2352x1568px. 45° field of view: 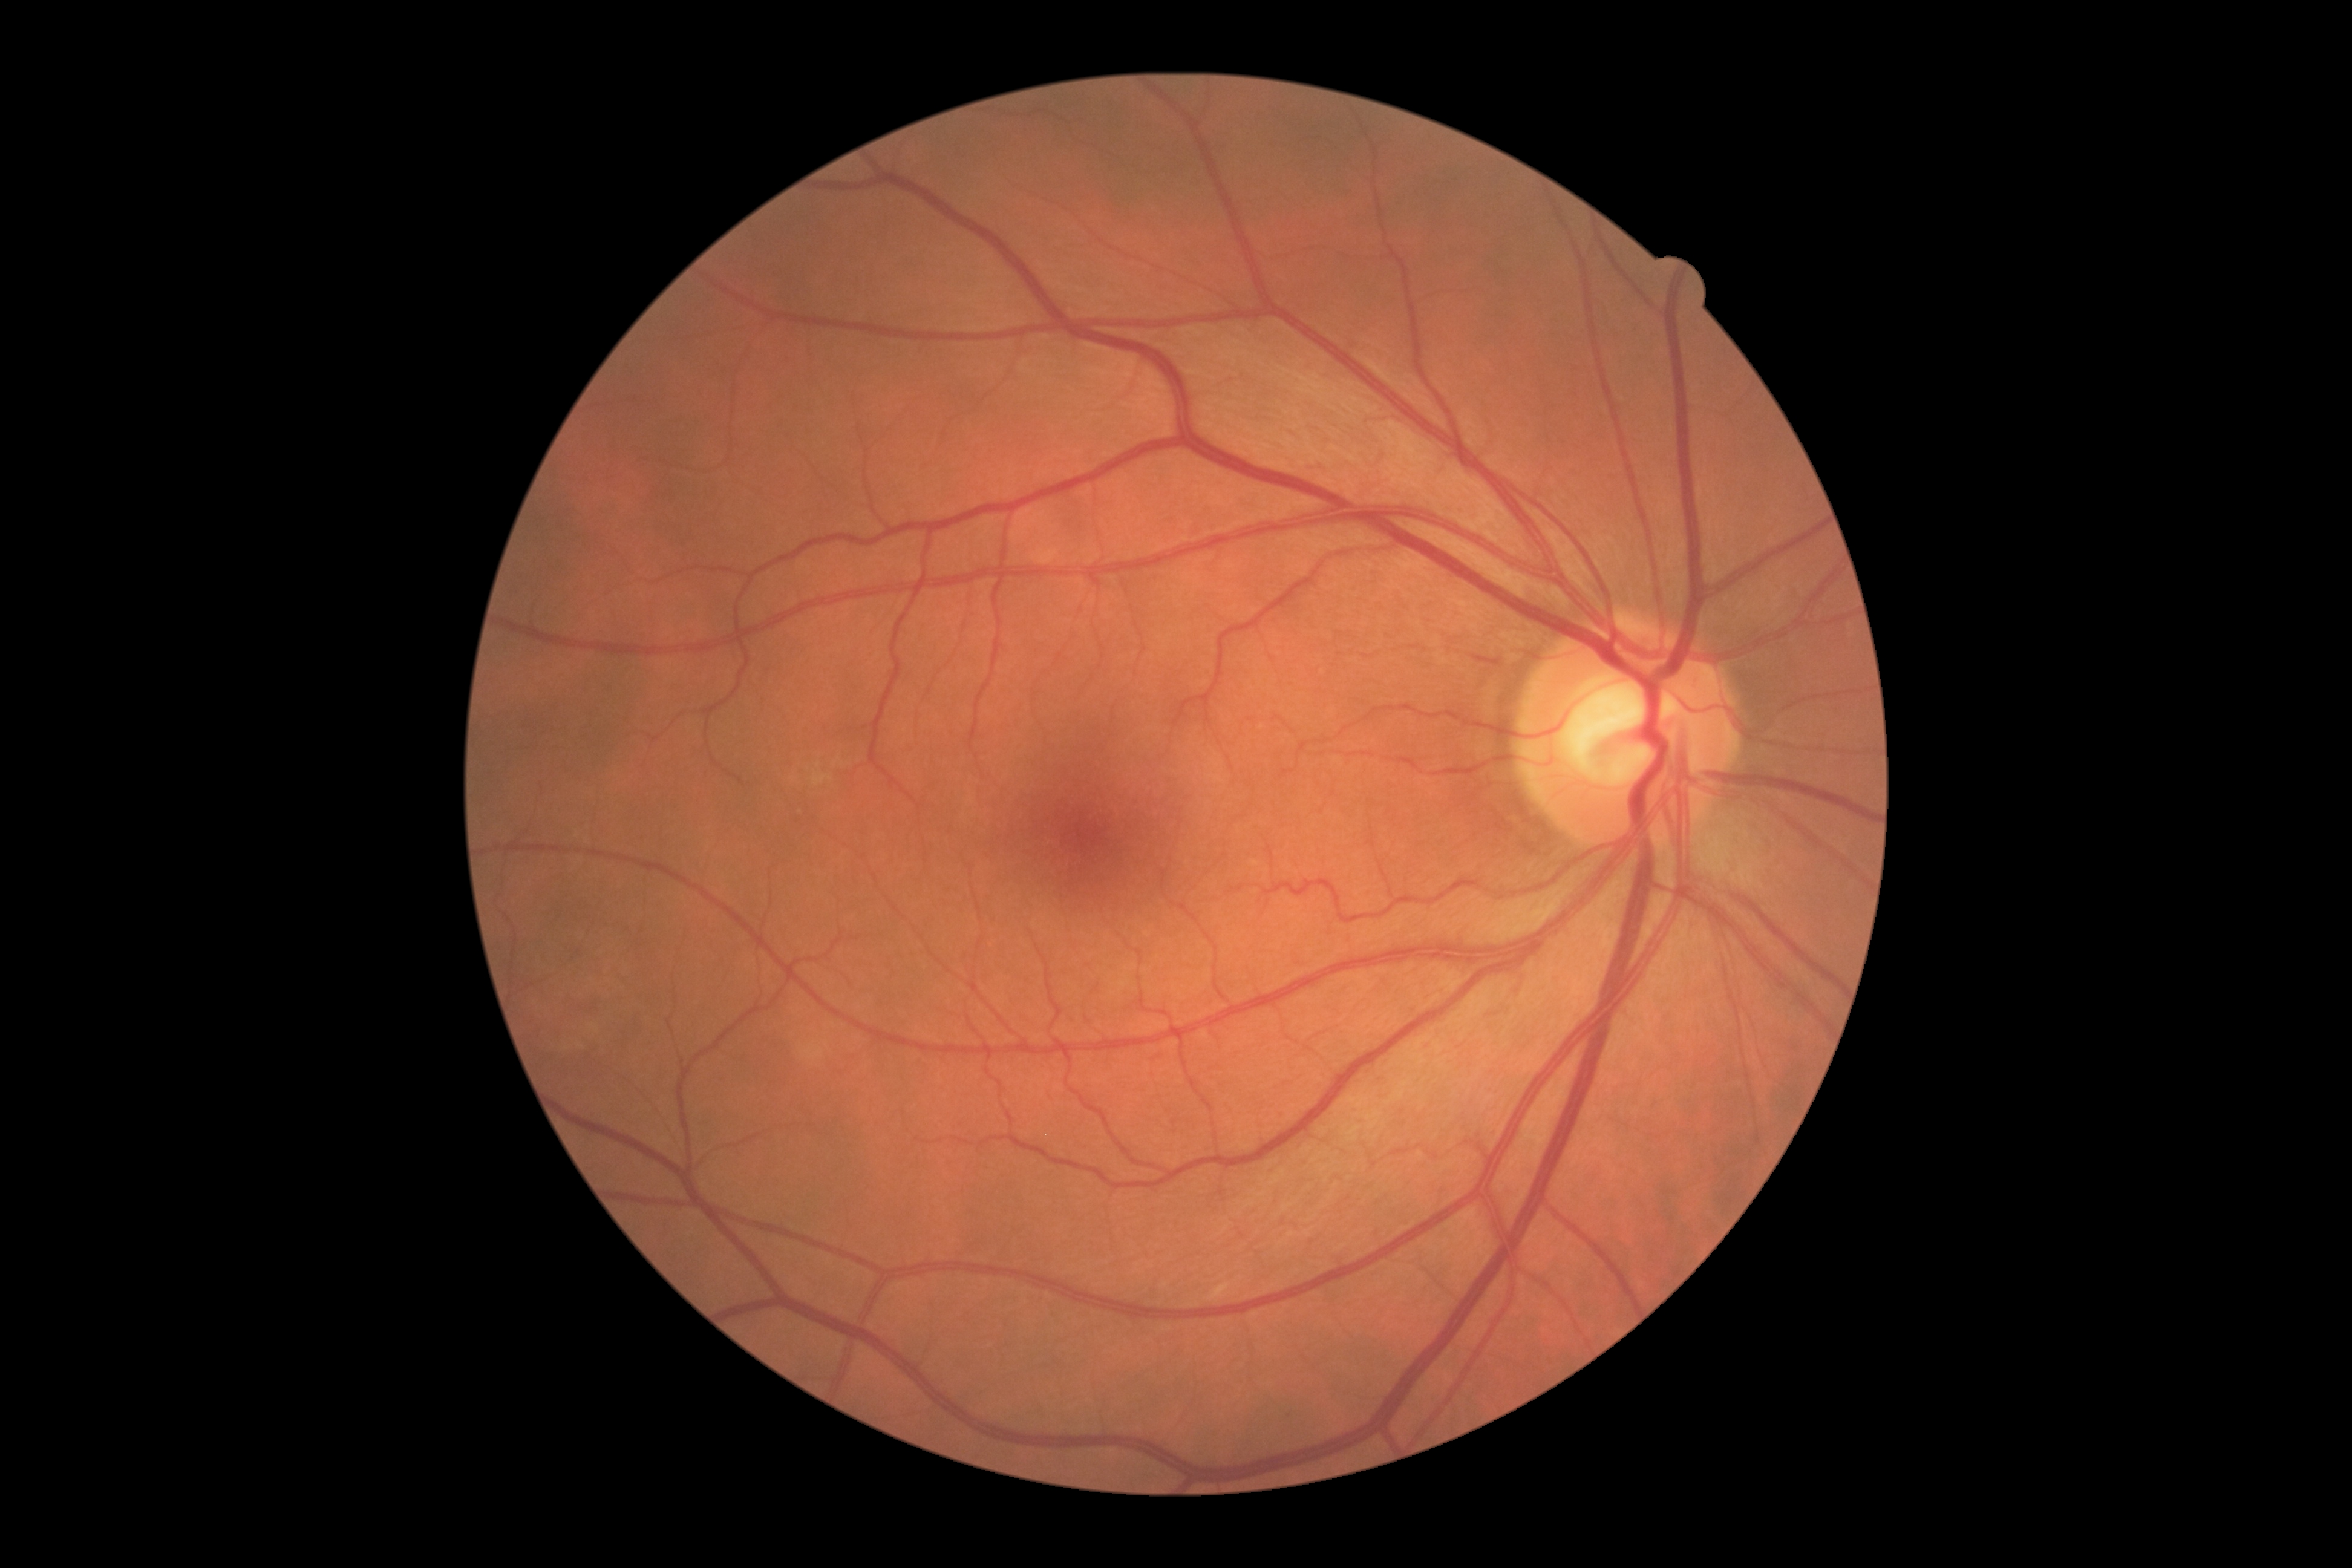
DR is 0 — no visible signs of diabetic retinopathy.